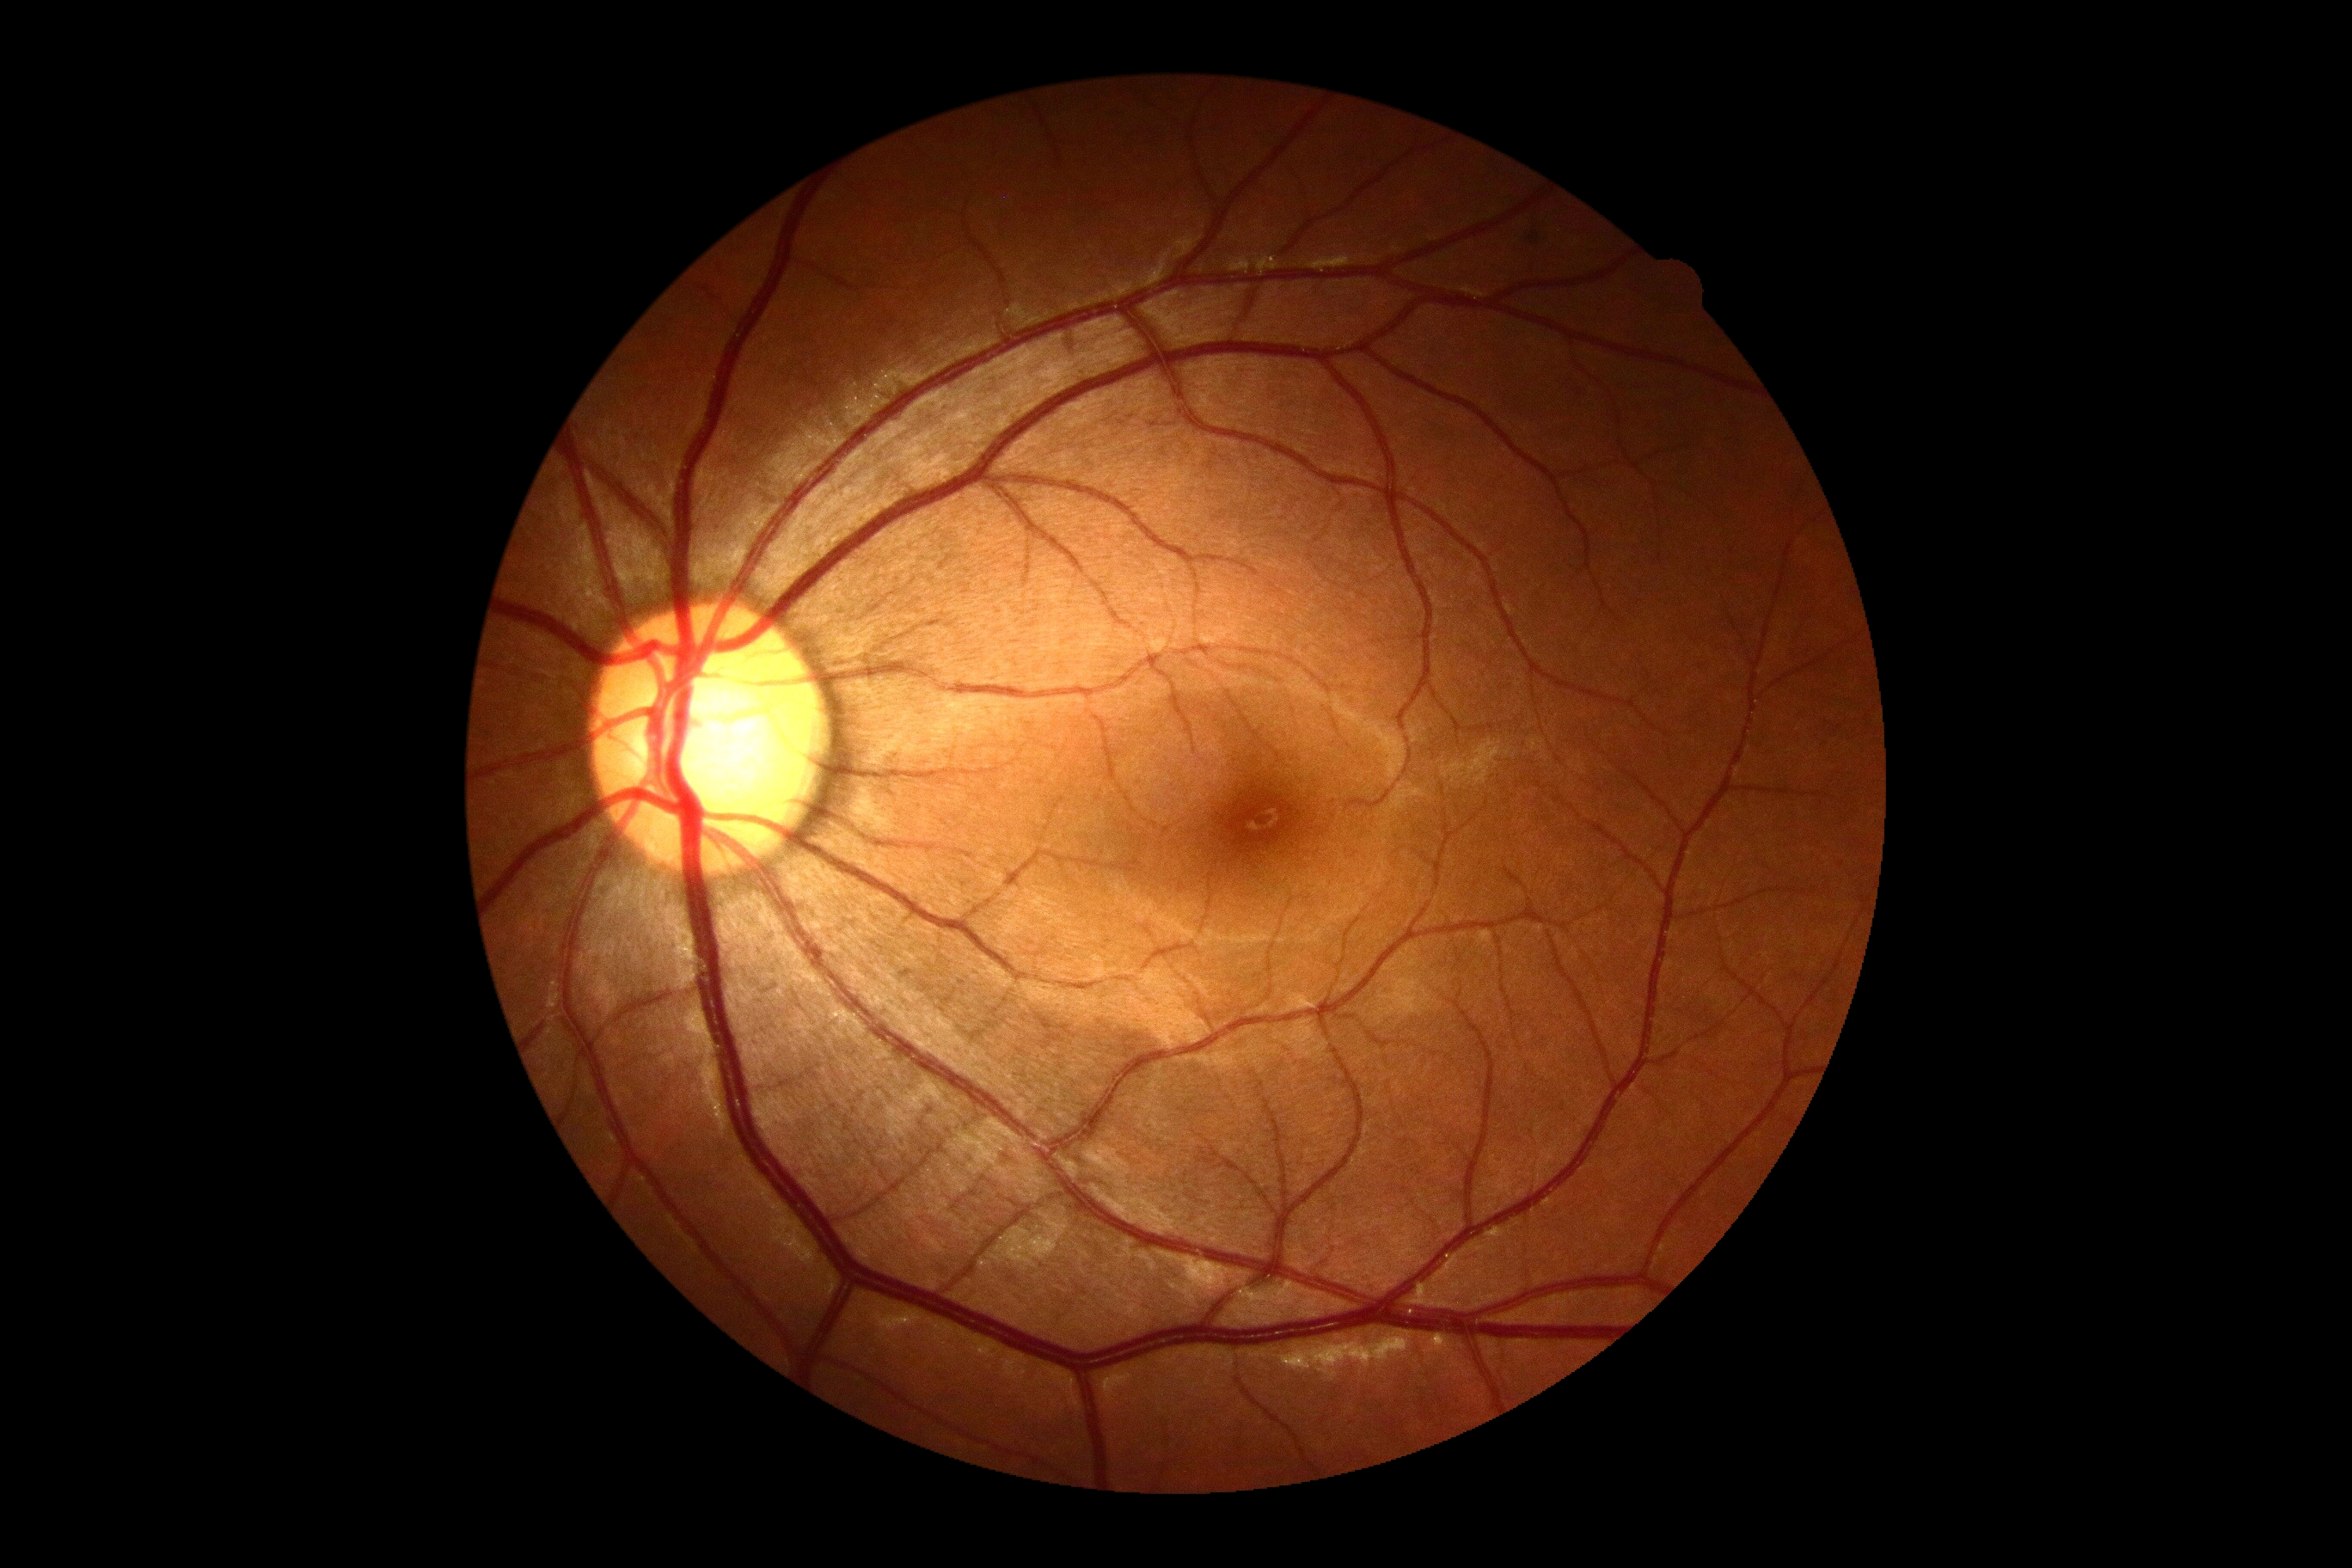 No DR findings.
DR: no apparent retinopathy (grade 0).